Posterior pole photograph — 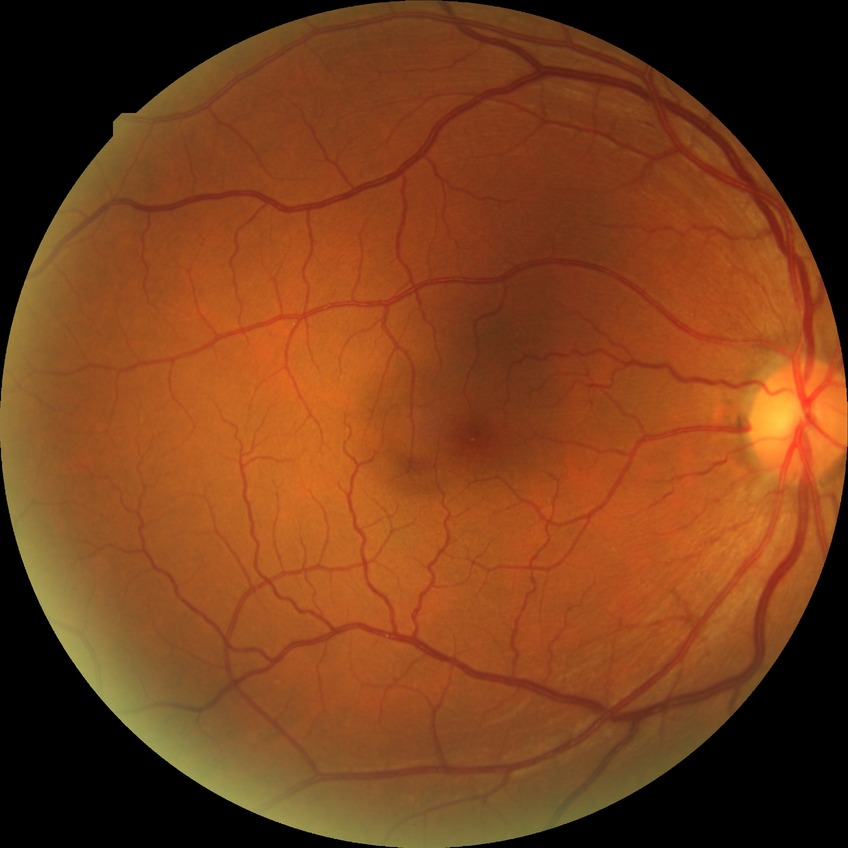
Retinopathy stage: no diabetic retinopathy.